CFP · image size 2102x1736 — 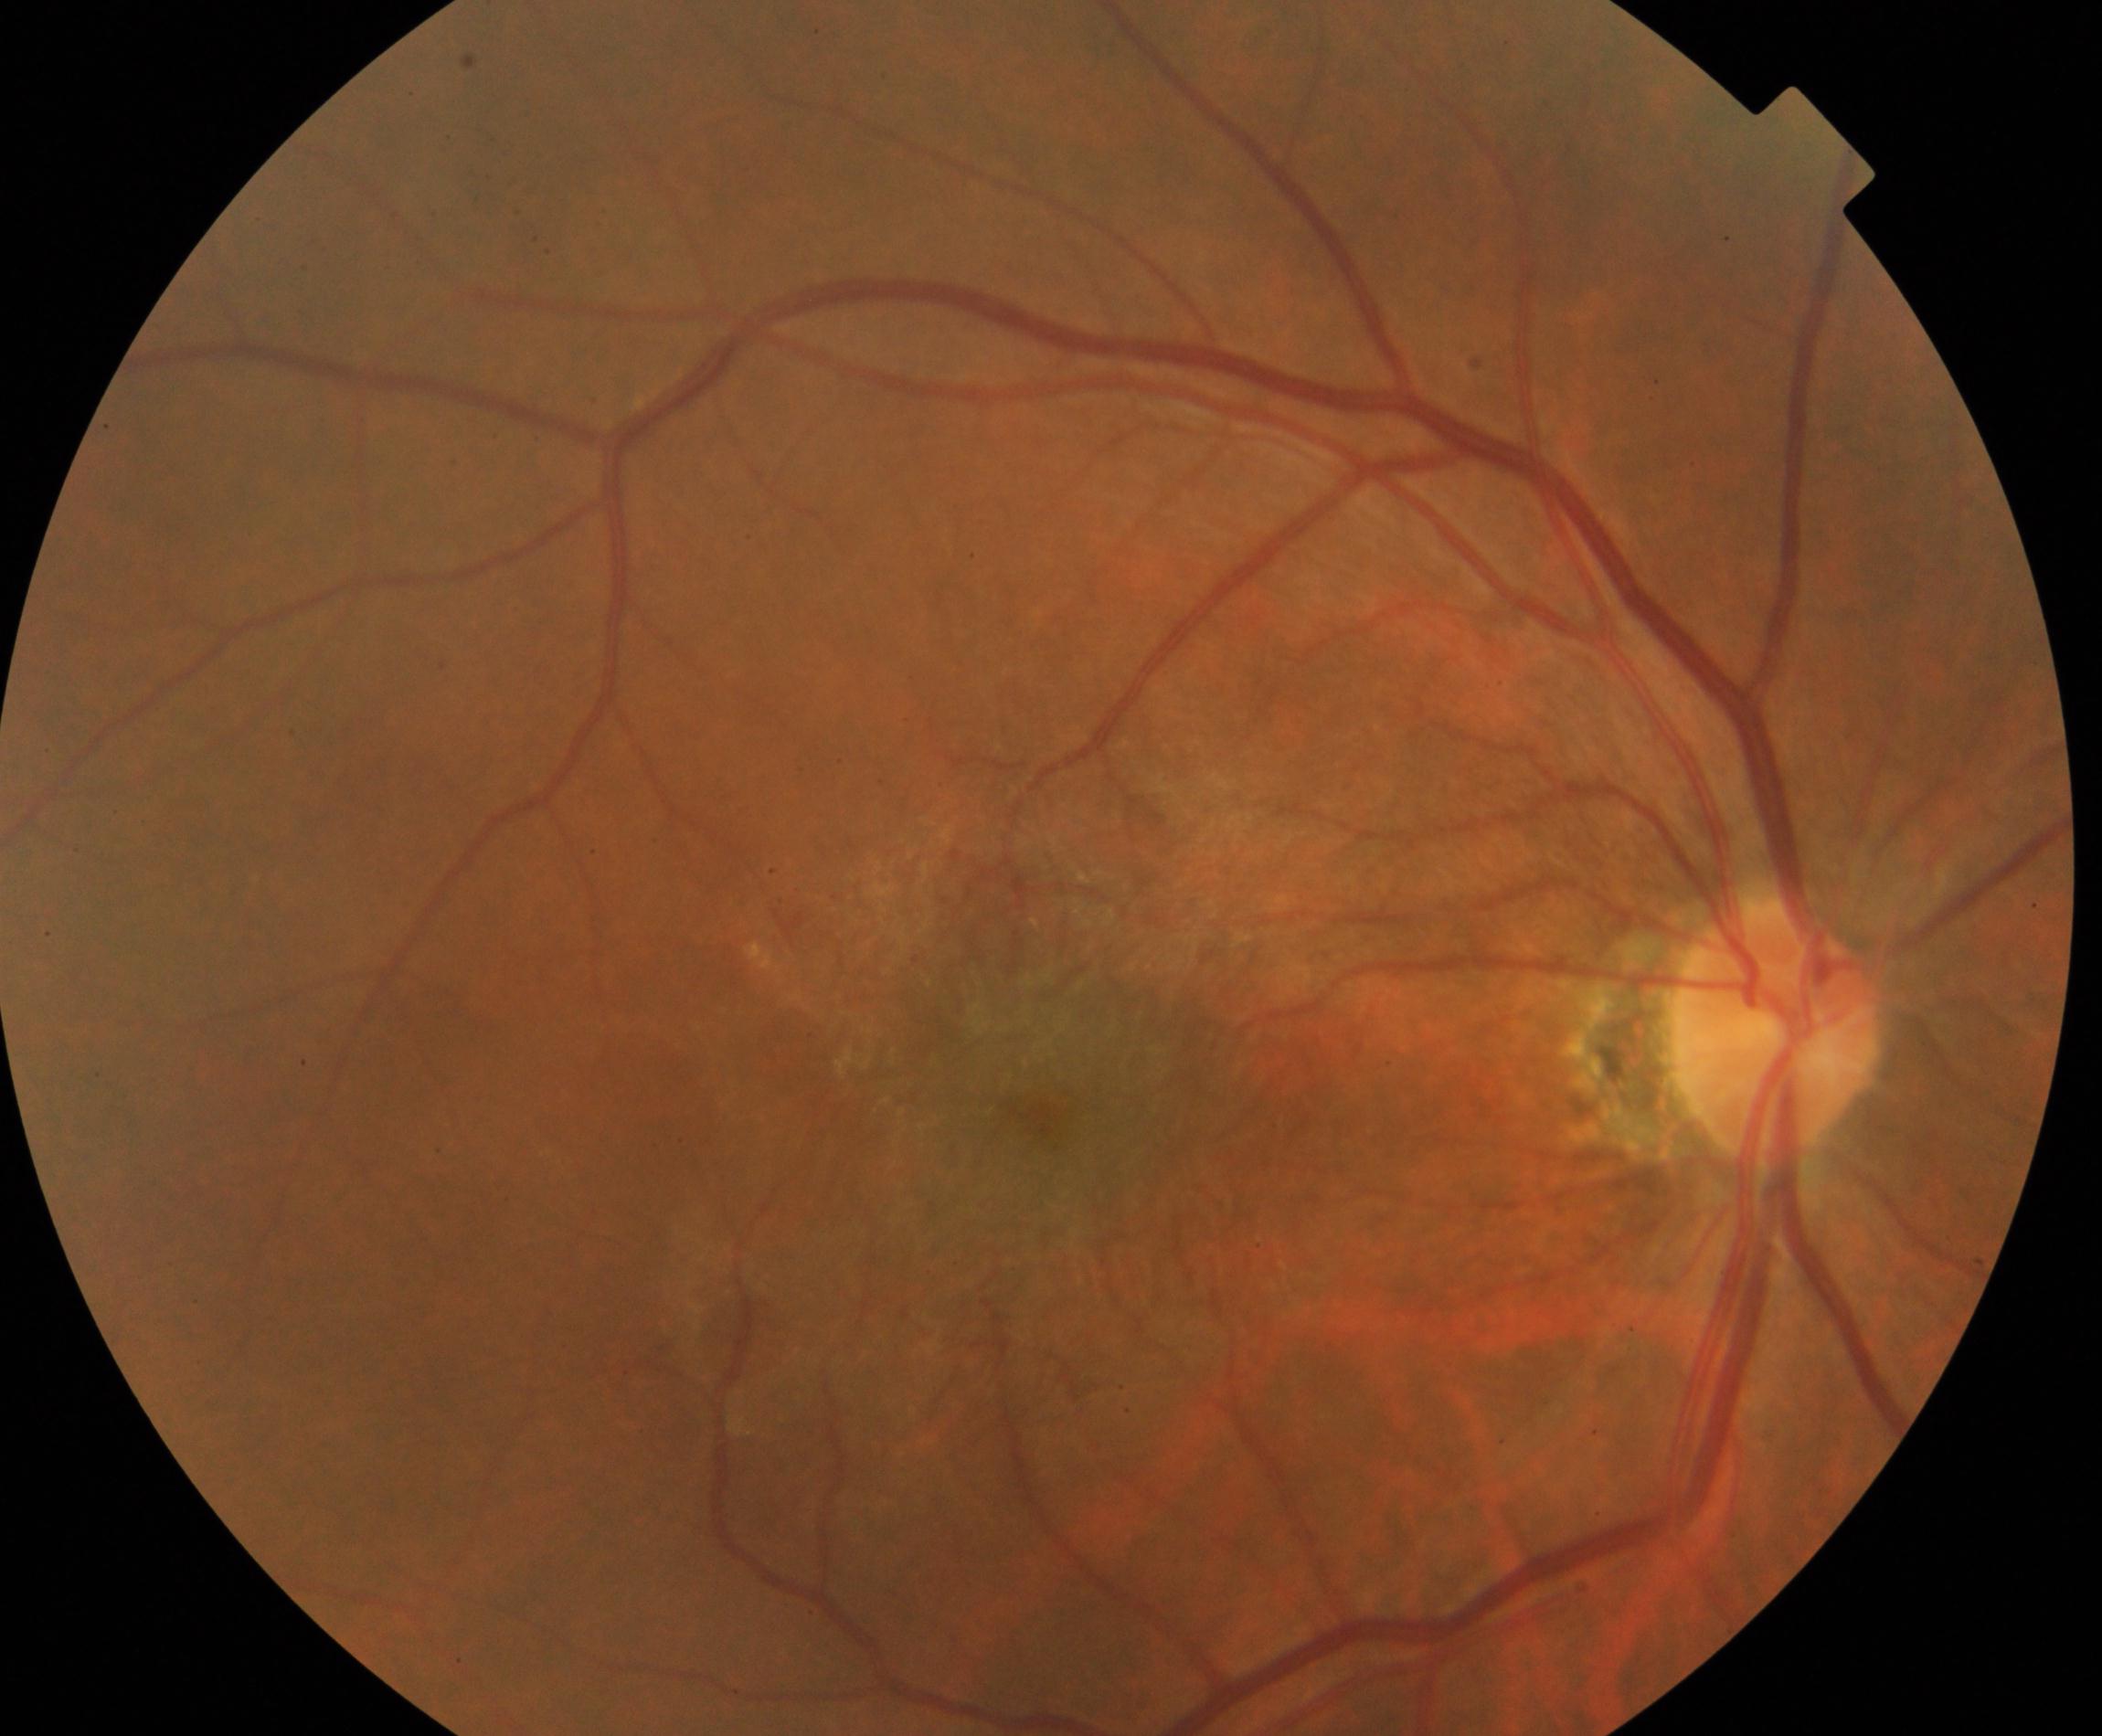 Consistent with epiretinal membrane.